Wide-field fundus photograph of an infant — 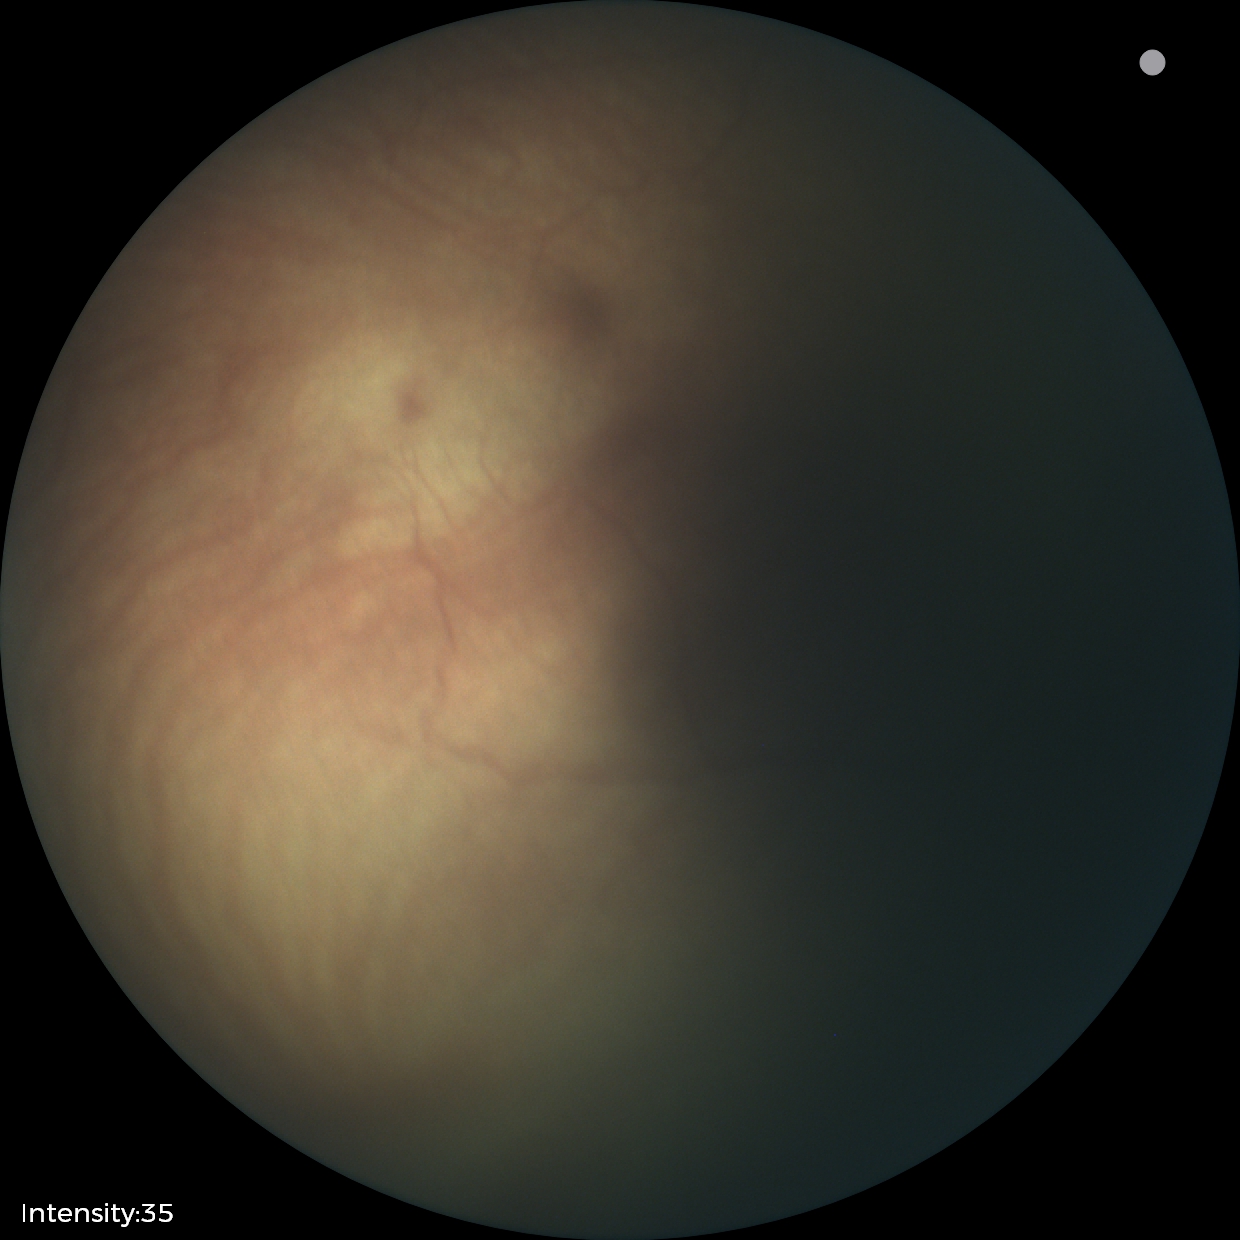 Screening series with ROP stage 0.
Plus disease absent.